Nonmydriatic fundus photograph; fundus photo; 45° FOV
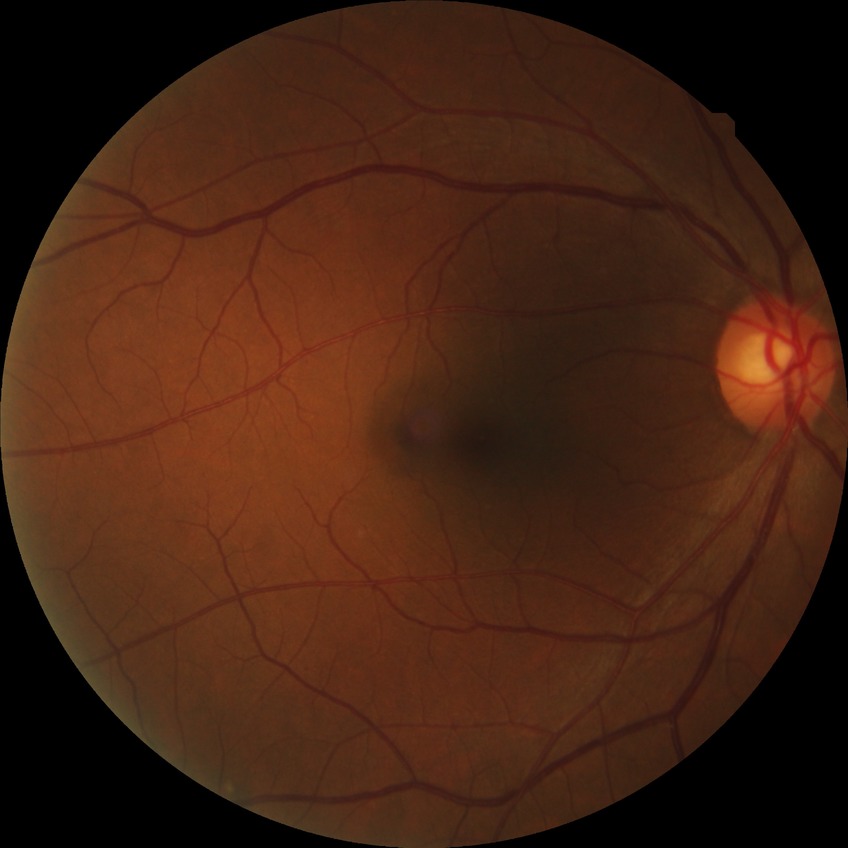 Assessment:
* DR class: non-proliferative diabetic retinopathy
* Davis grading: simple diabetic retinopathy